Image size 2352x1568.
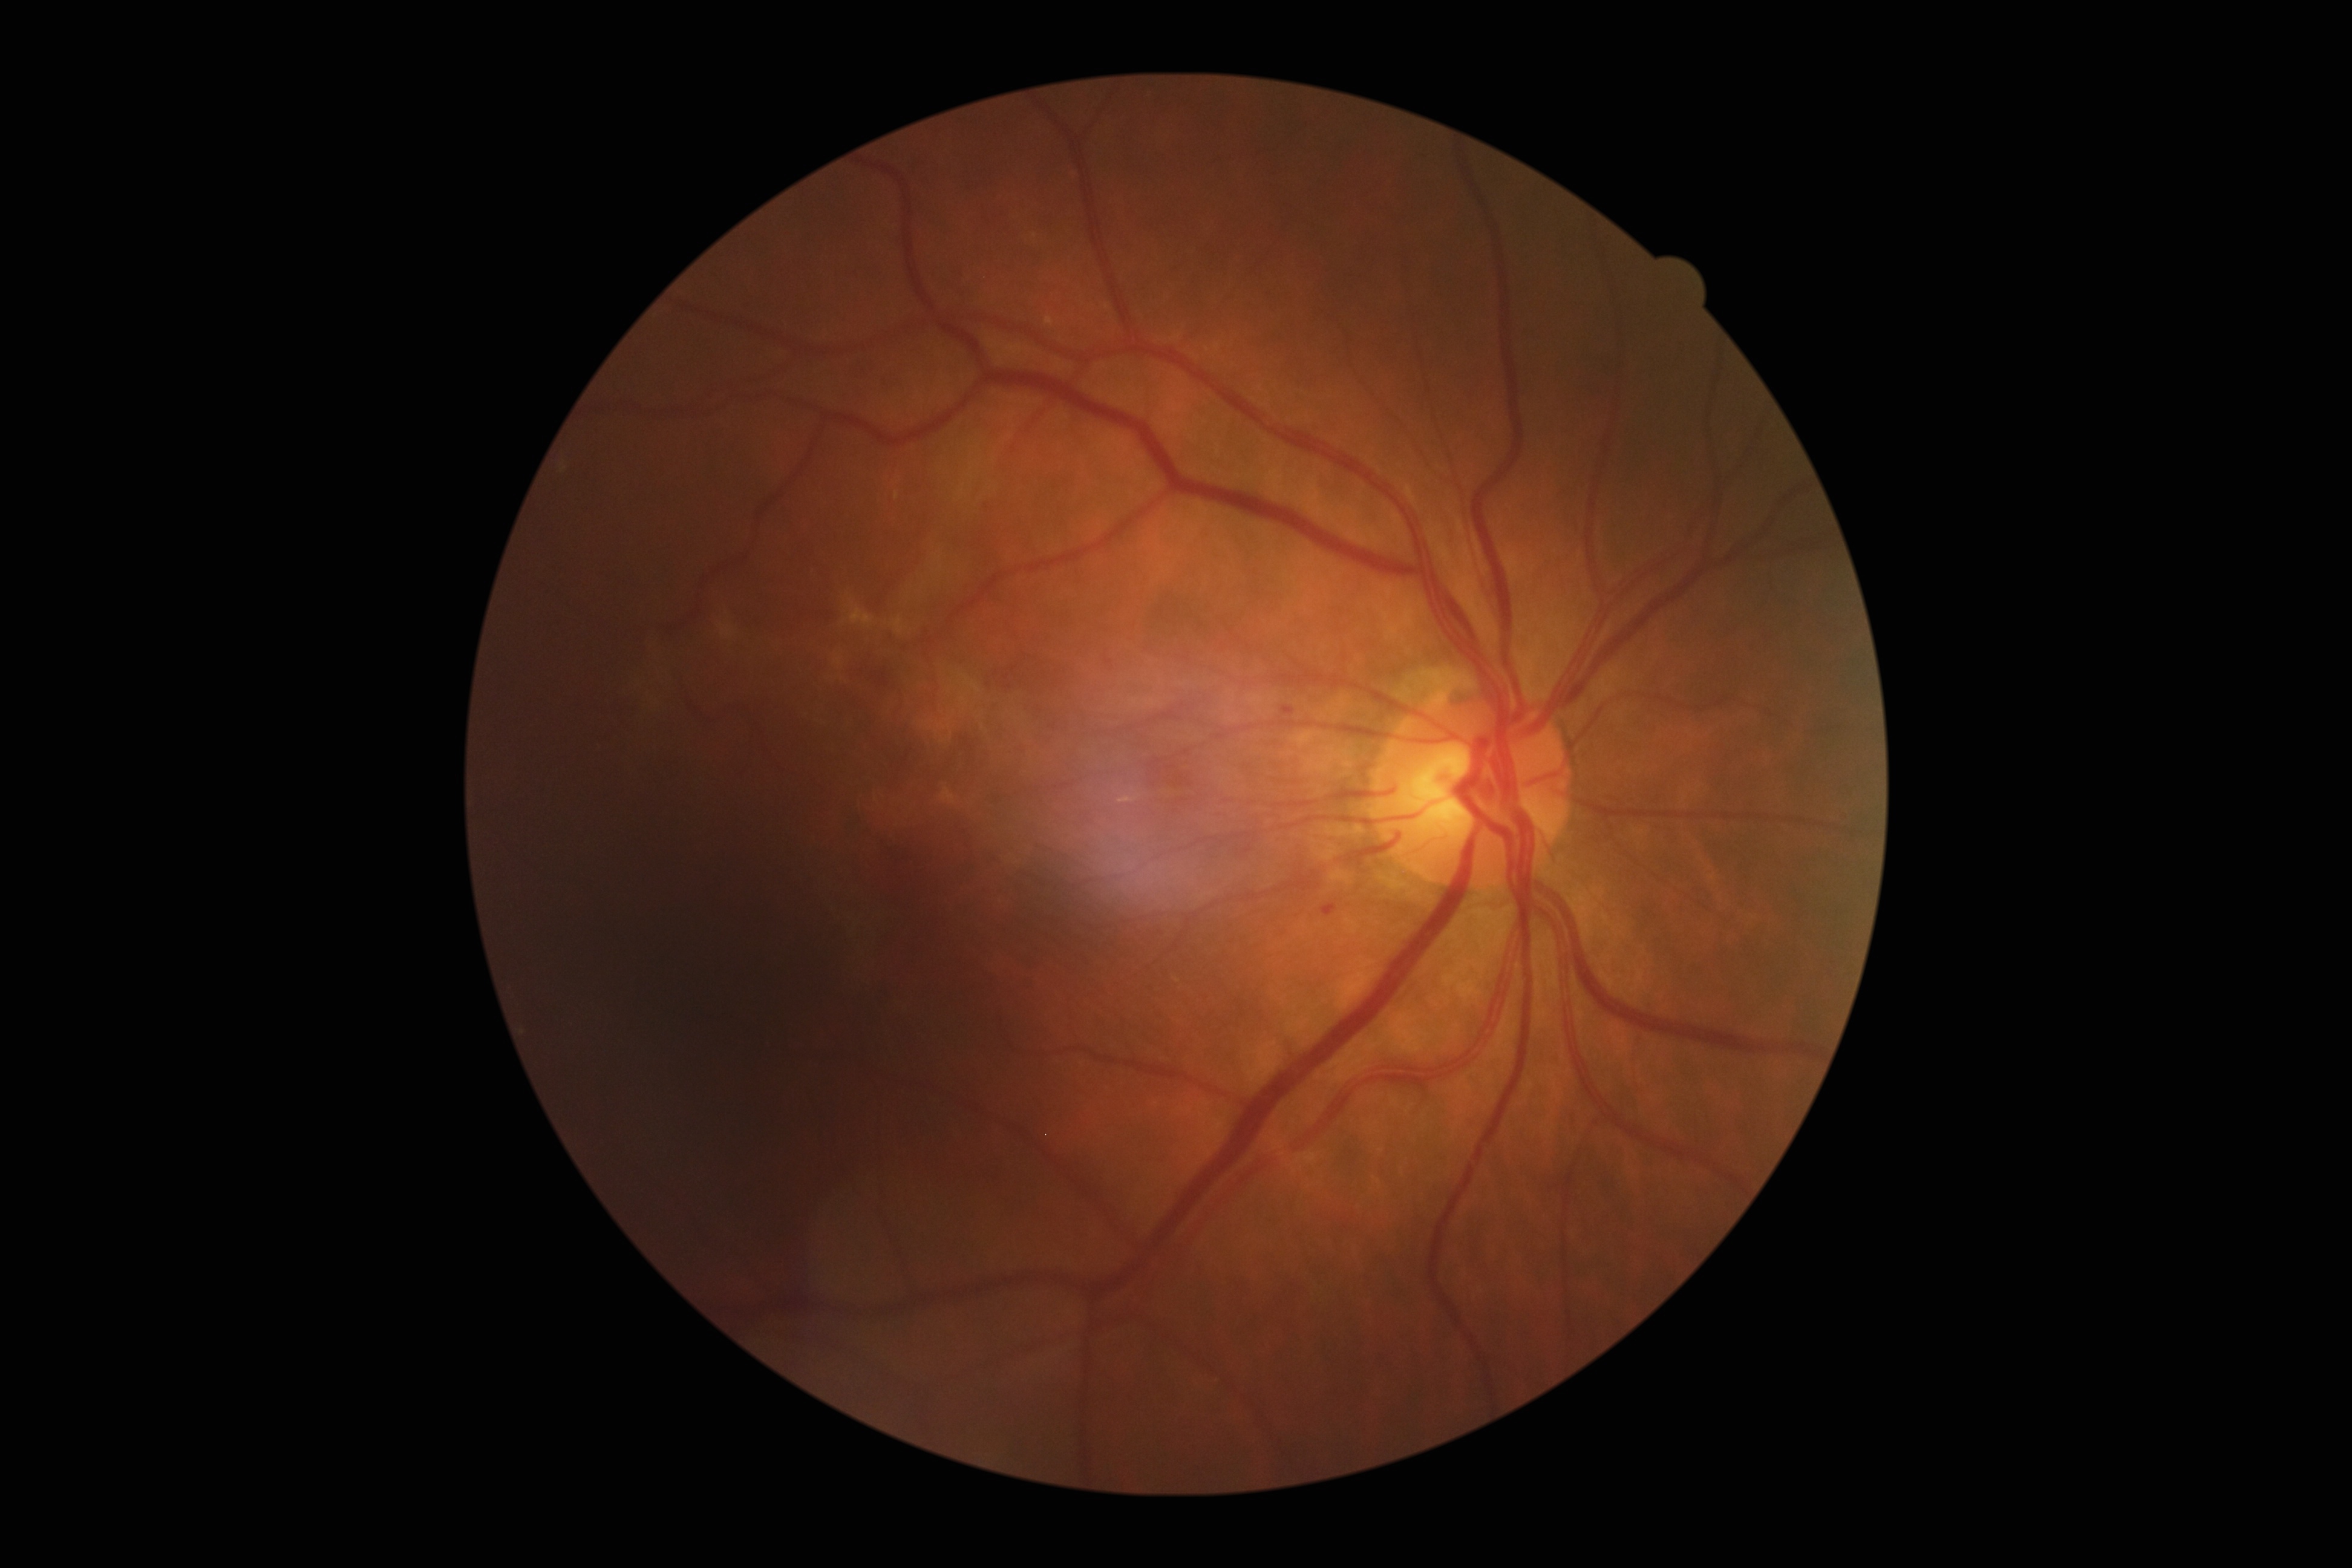

Diabetic retinopathy grade is 1/4
• microaneurysms: {"x1": 1282, "y1": 705, "x2": 1296, "y2": 717}; {"x1": 1323, "y1": 906, "x2": 1338, "y2": 919}
• Small microaneurysms near 987/508
• soft exudates: none identified
• hemorrhages: {"x1": 1146, "y1": 756, "x2": 1214, "y2": 812}
• hard exudates: none identified